Graded on the modified Davis scale — 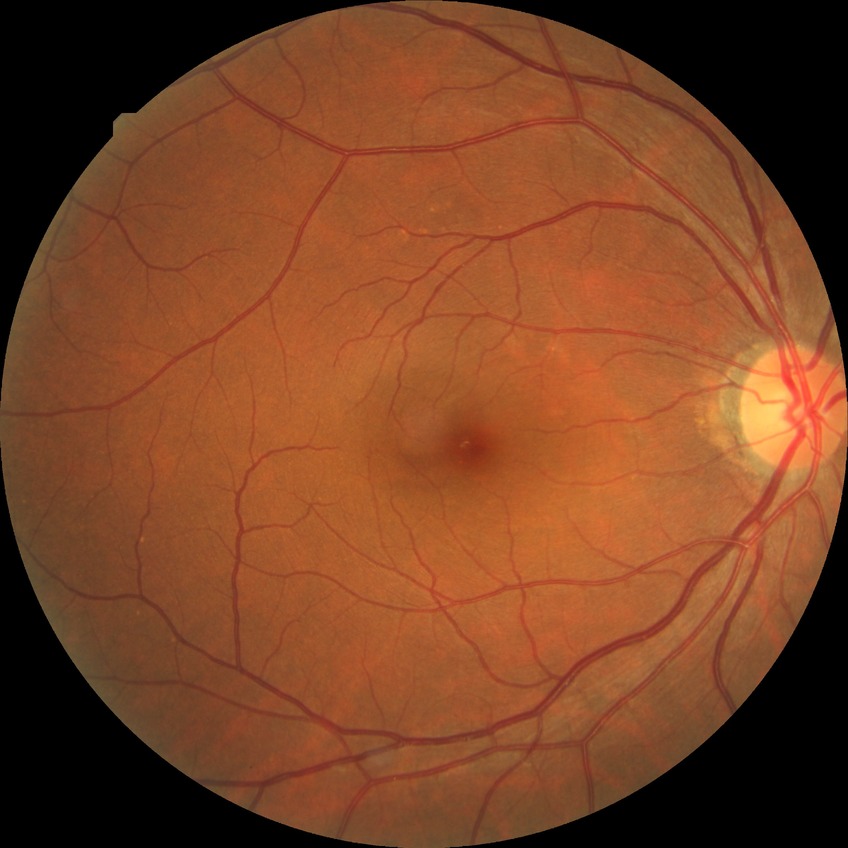
Davis grade: NDR.
No diabetic retinal disease findings.